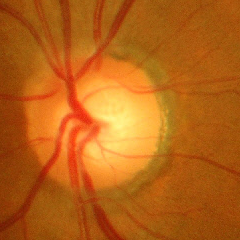 This fundus photograph shows advanced-stage glaucoma.